Optic nerve head photograph. Cropped from a 35-degree field of view. Mydriatic:
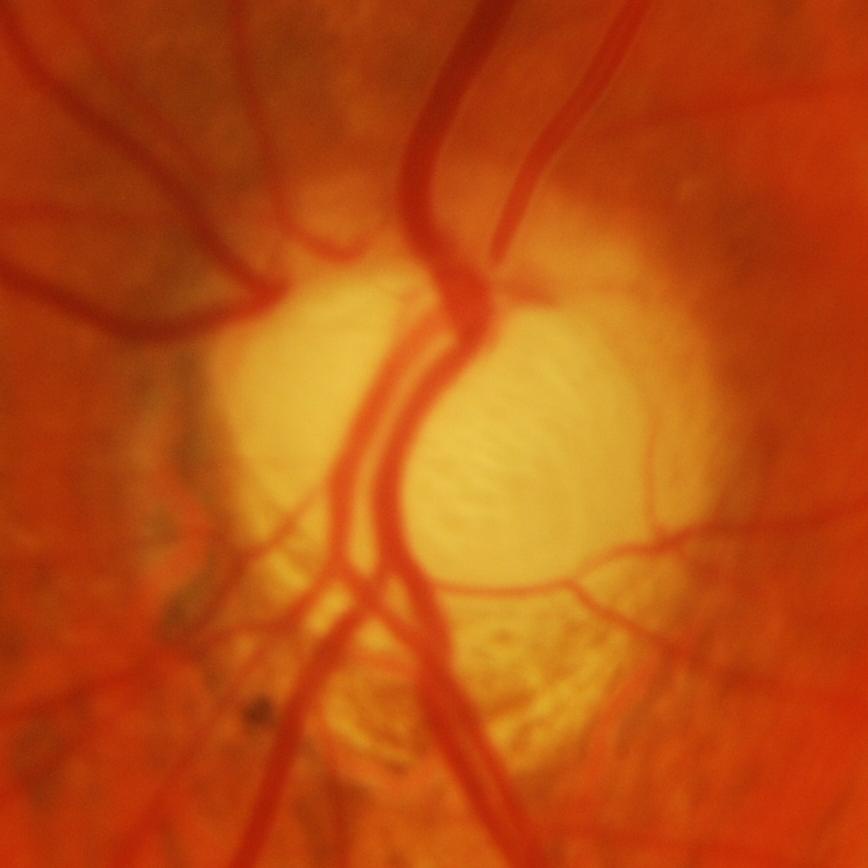

Q: What is the glaucoma diagnosis?
A: Evidence of glaucoma.